1932x1932, 45° FOV.
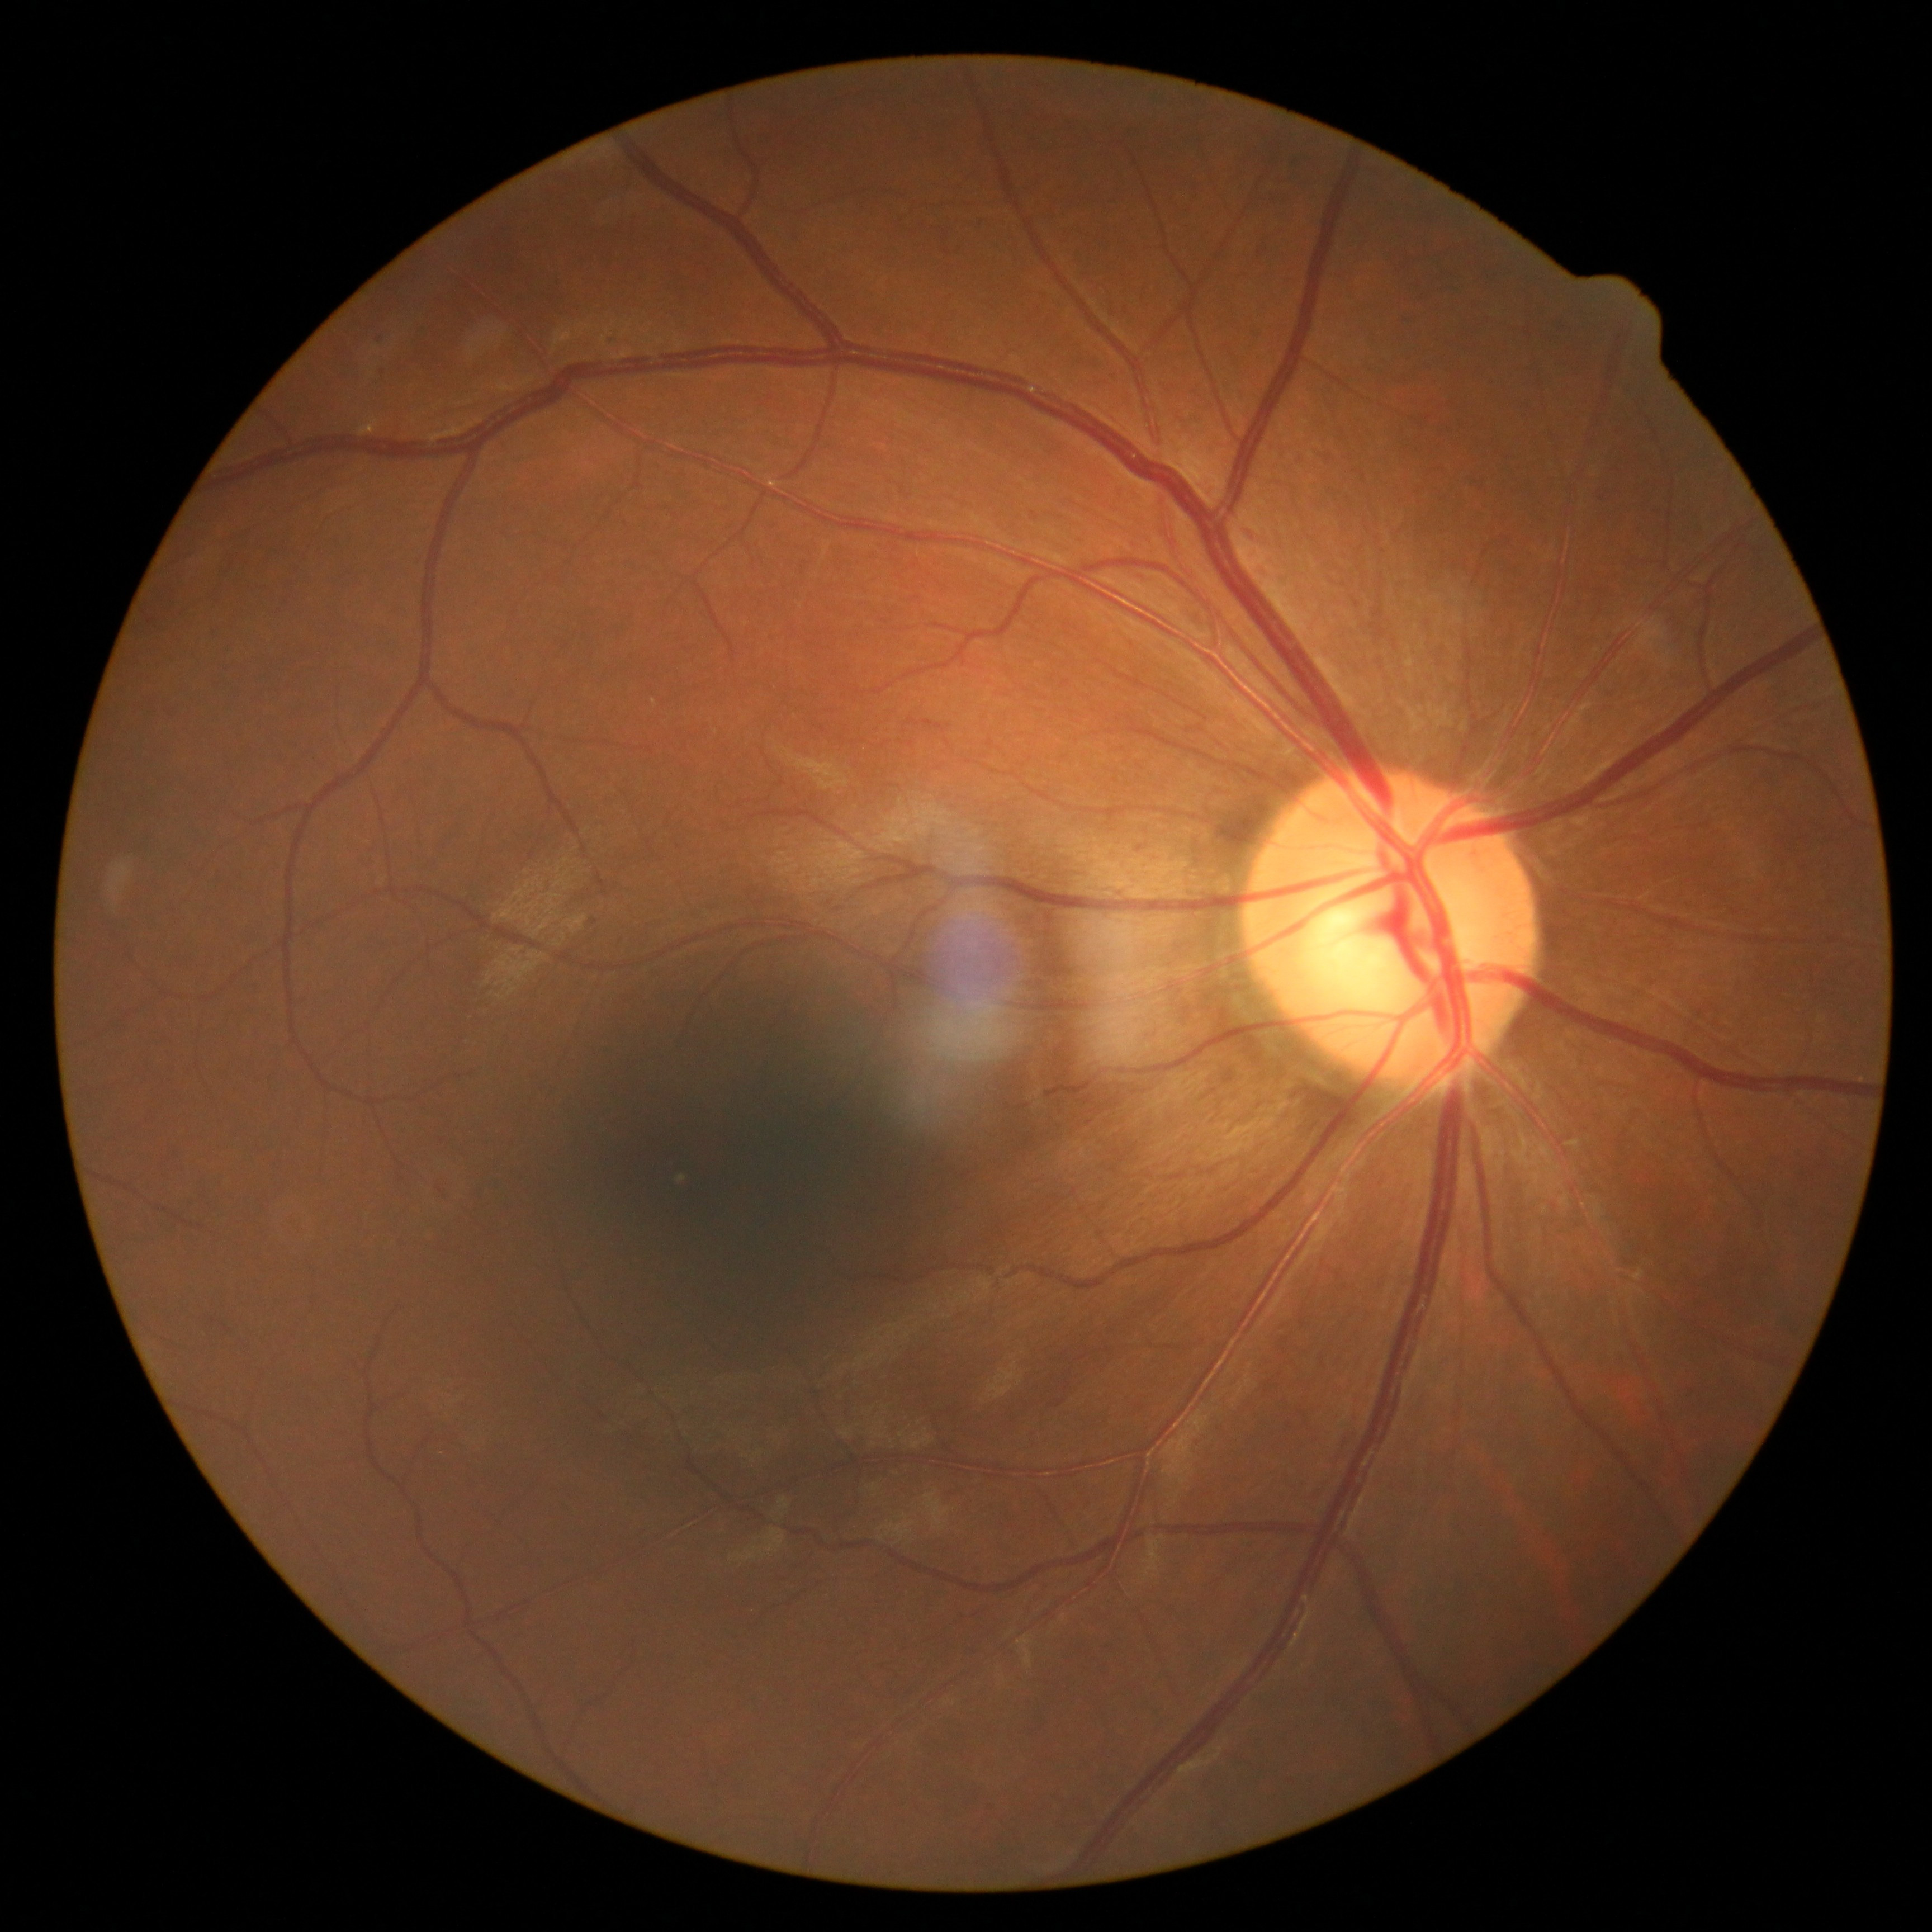

Retinopathy grade: 1/4. Disease class: non-proliferative diabetic retinopathy.